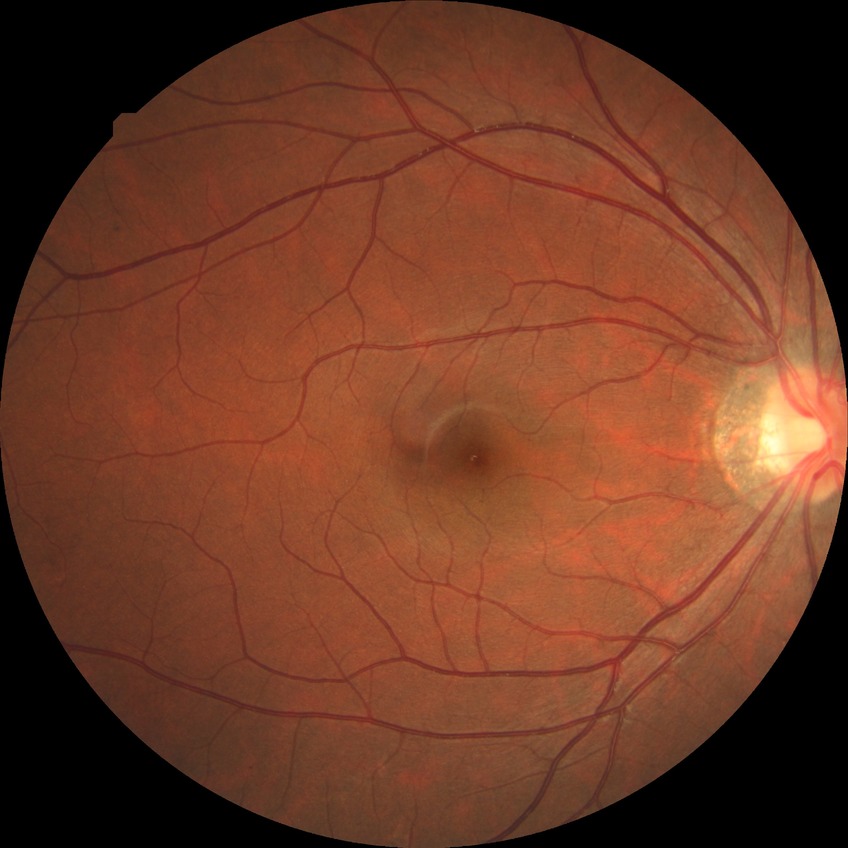

Davis grading: no diabetic retinopathy.